Acquired on the Phoenix ICON; image size 1240x1240; wide-field contact fundus photograph of an infant — 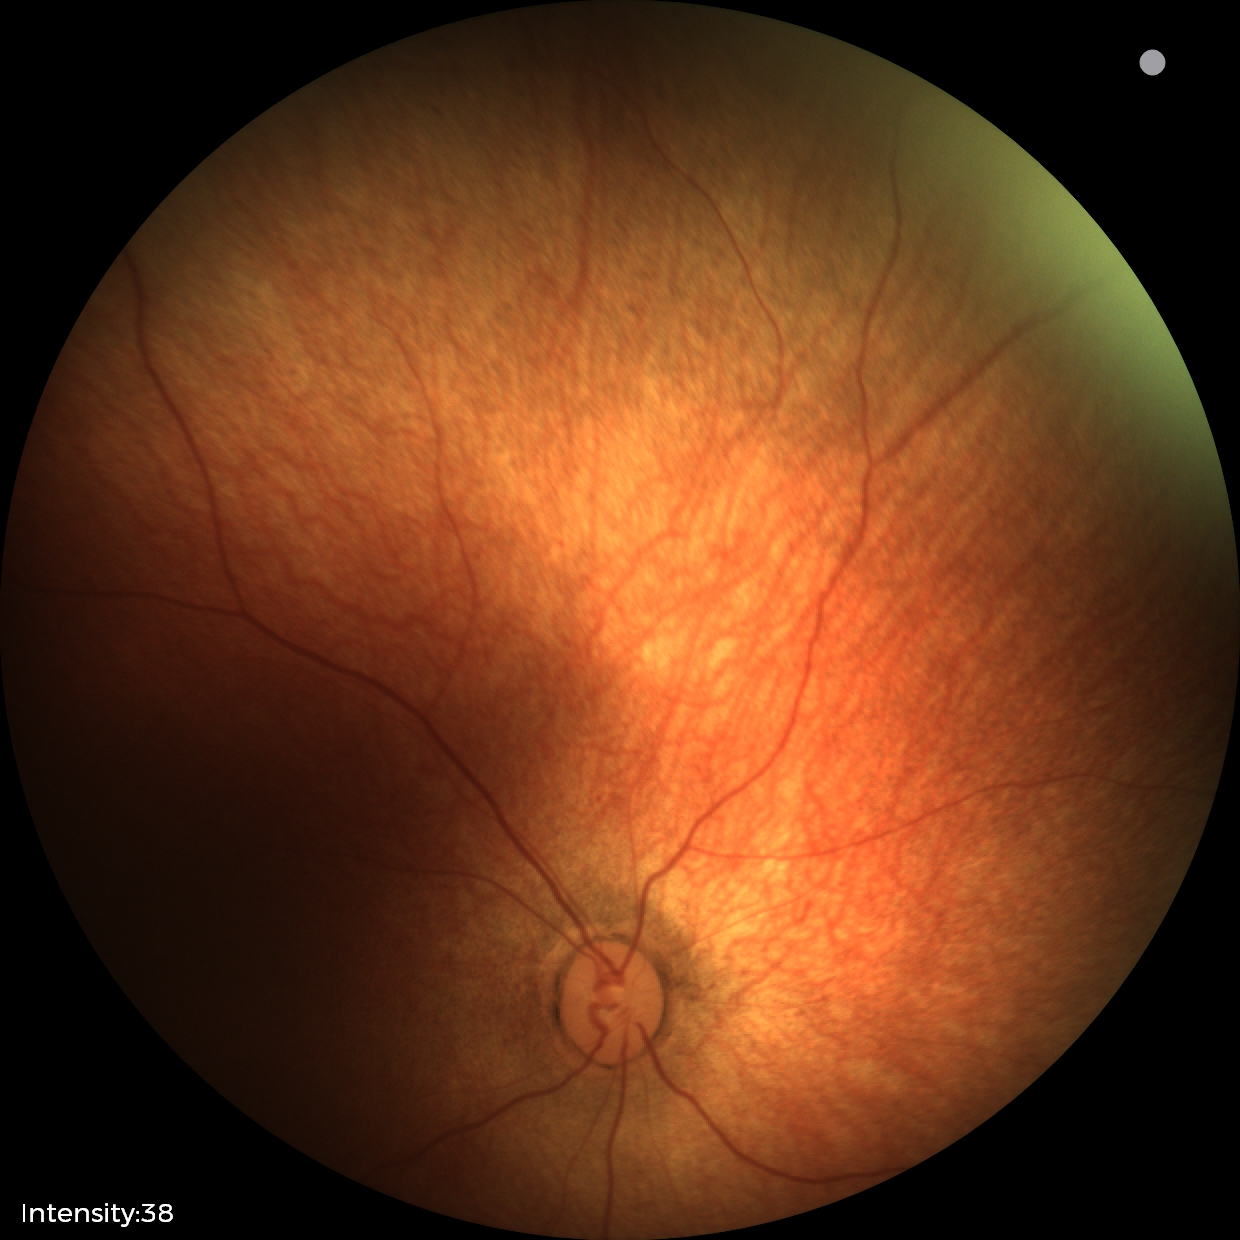
Assessment: physiological appearance with no retinal pathology.